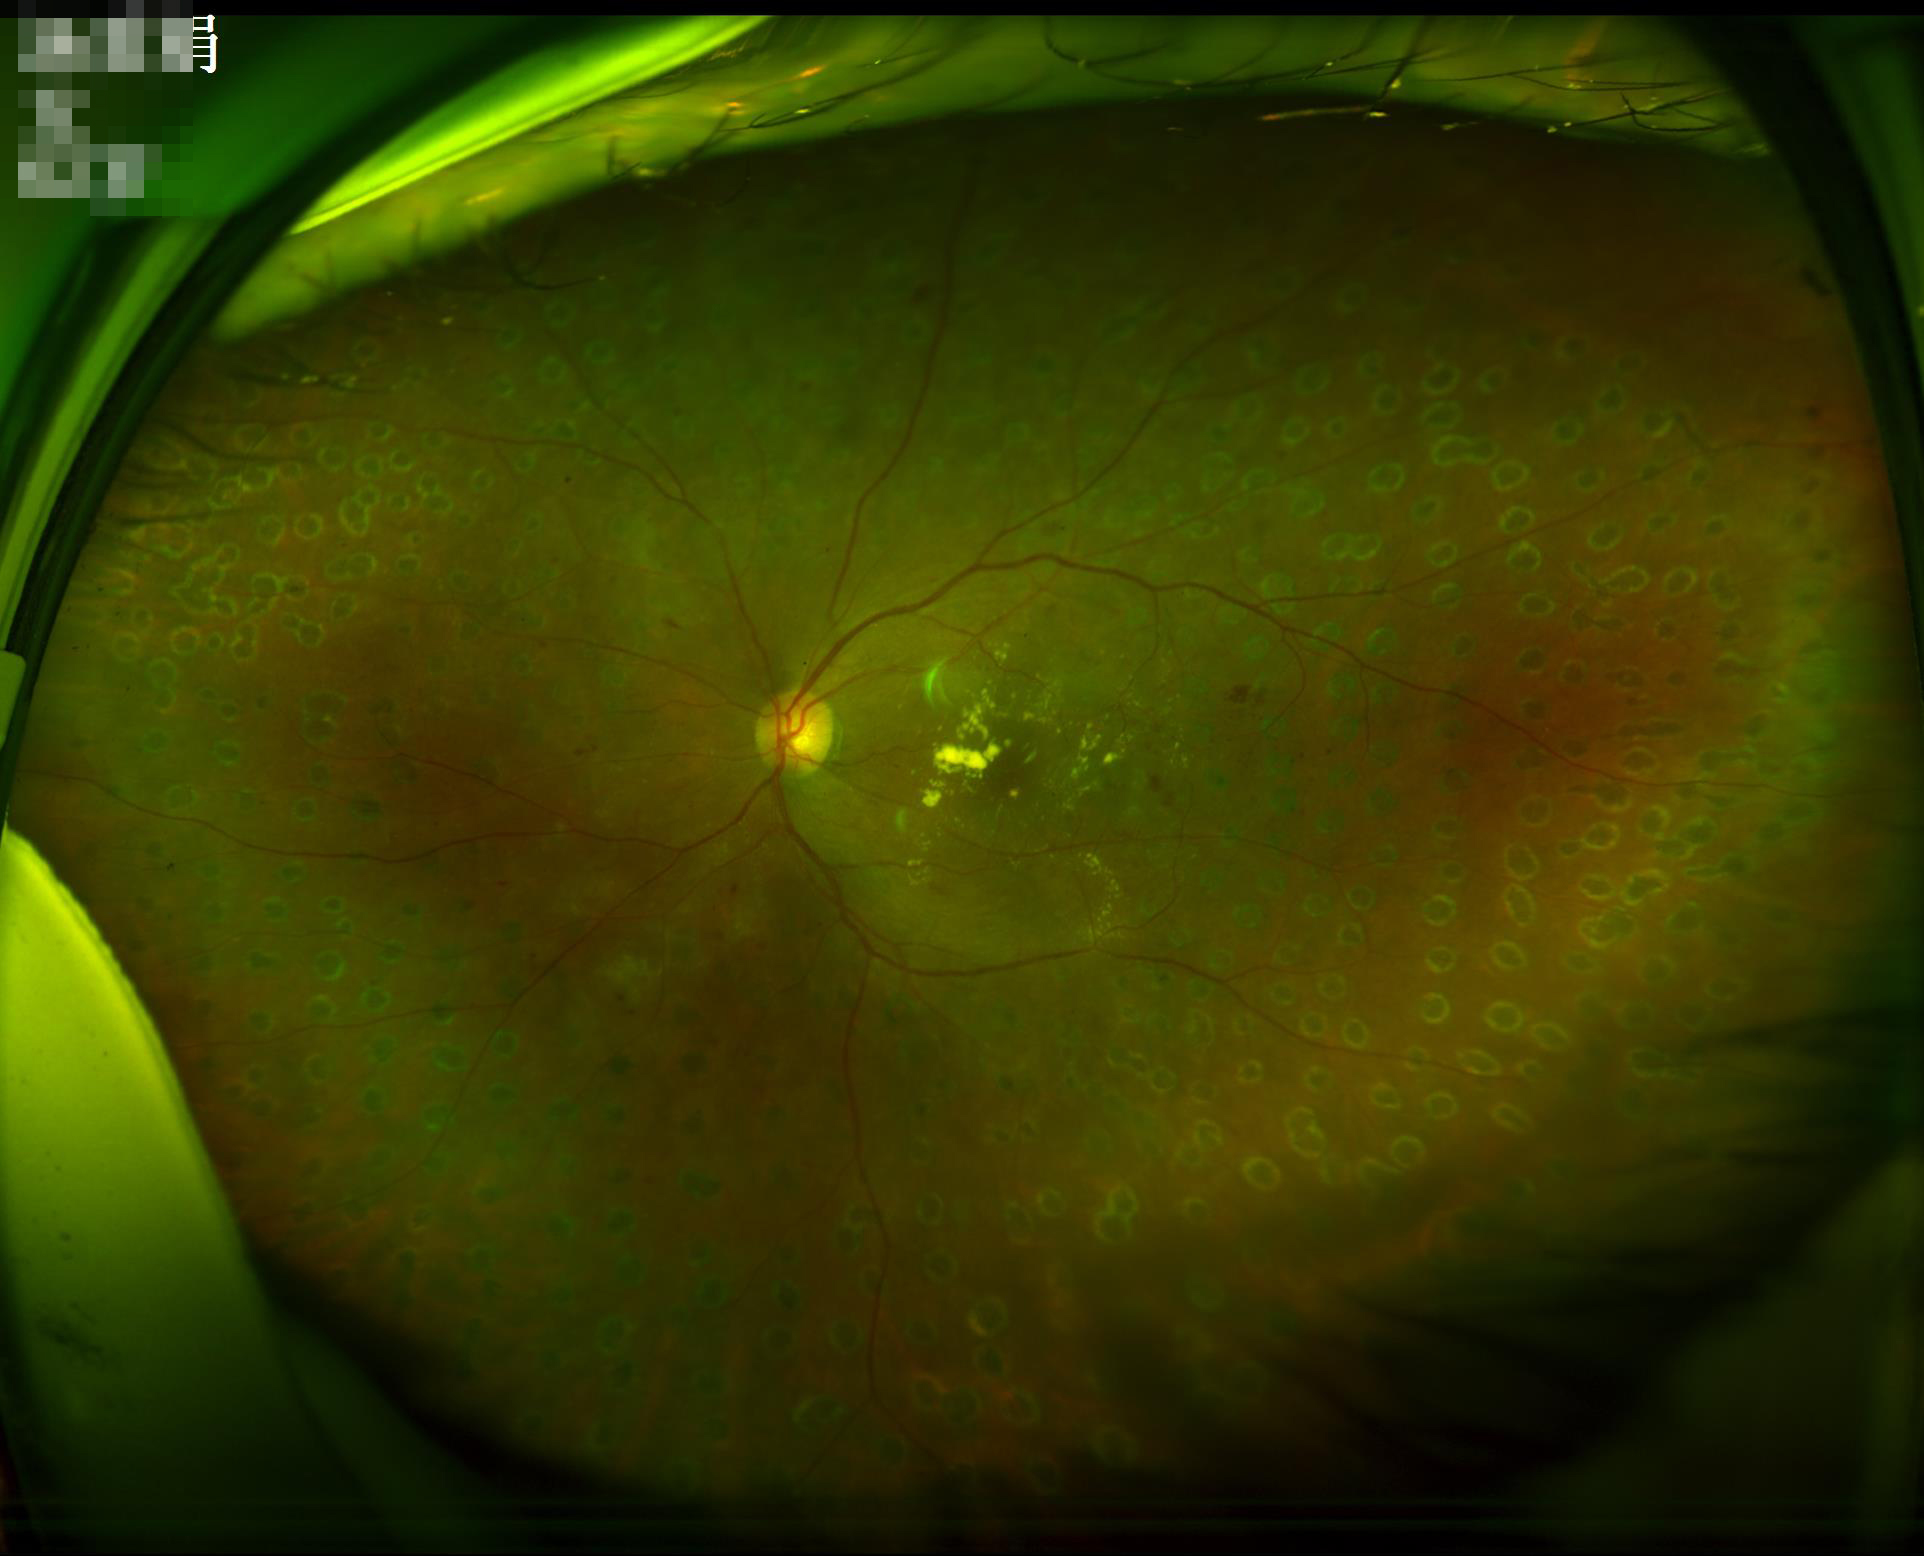
Image is sharp throughout the field. Vessels and details are readily distinguishable. Acceptable image quality.